NIDEK AFC-230
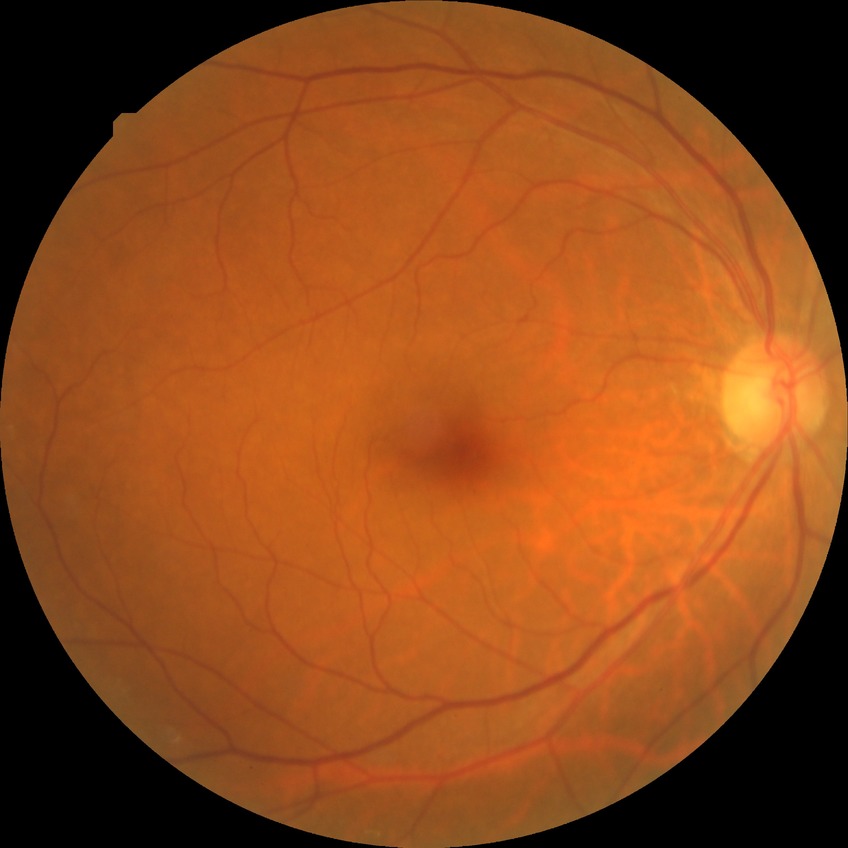
Diabetic retinopathy (DR): NDR (no diabetic retinopathy).